Image size 848x848; posterior pole photograph; modified Davis grading:
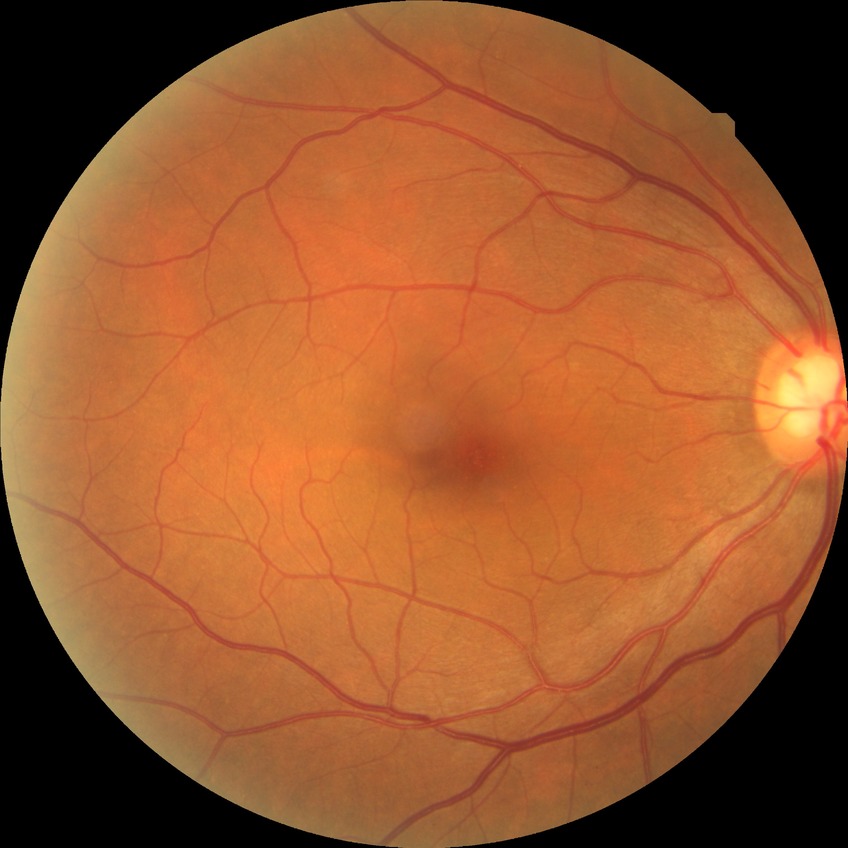
Diabetic retinopathy (DR): NDR (no diabetic retinopathy).